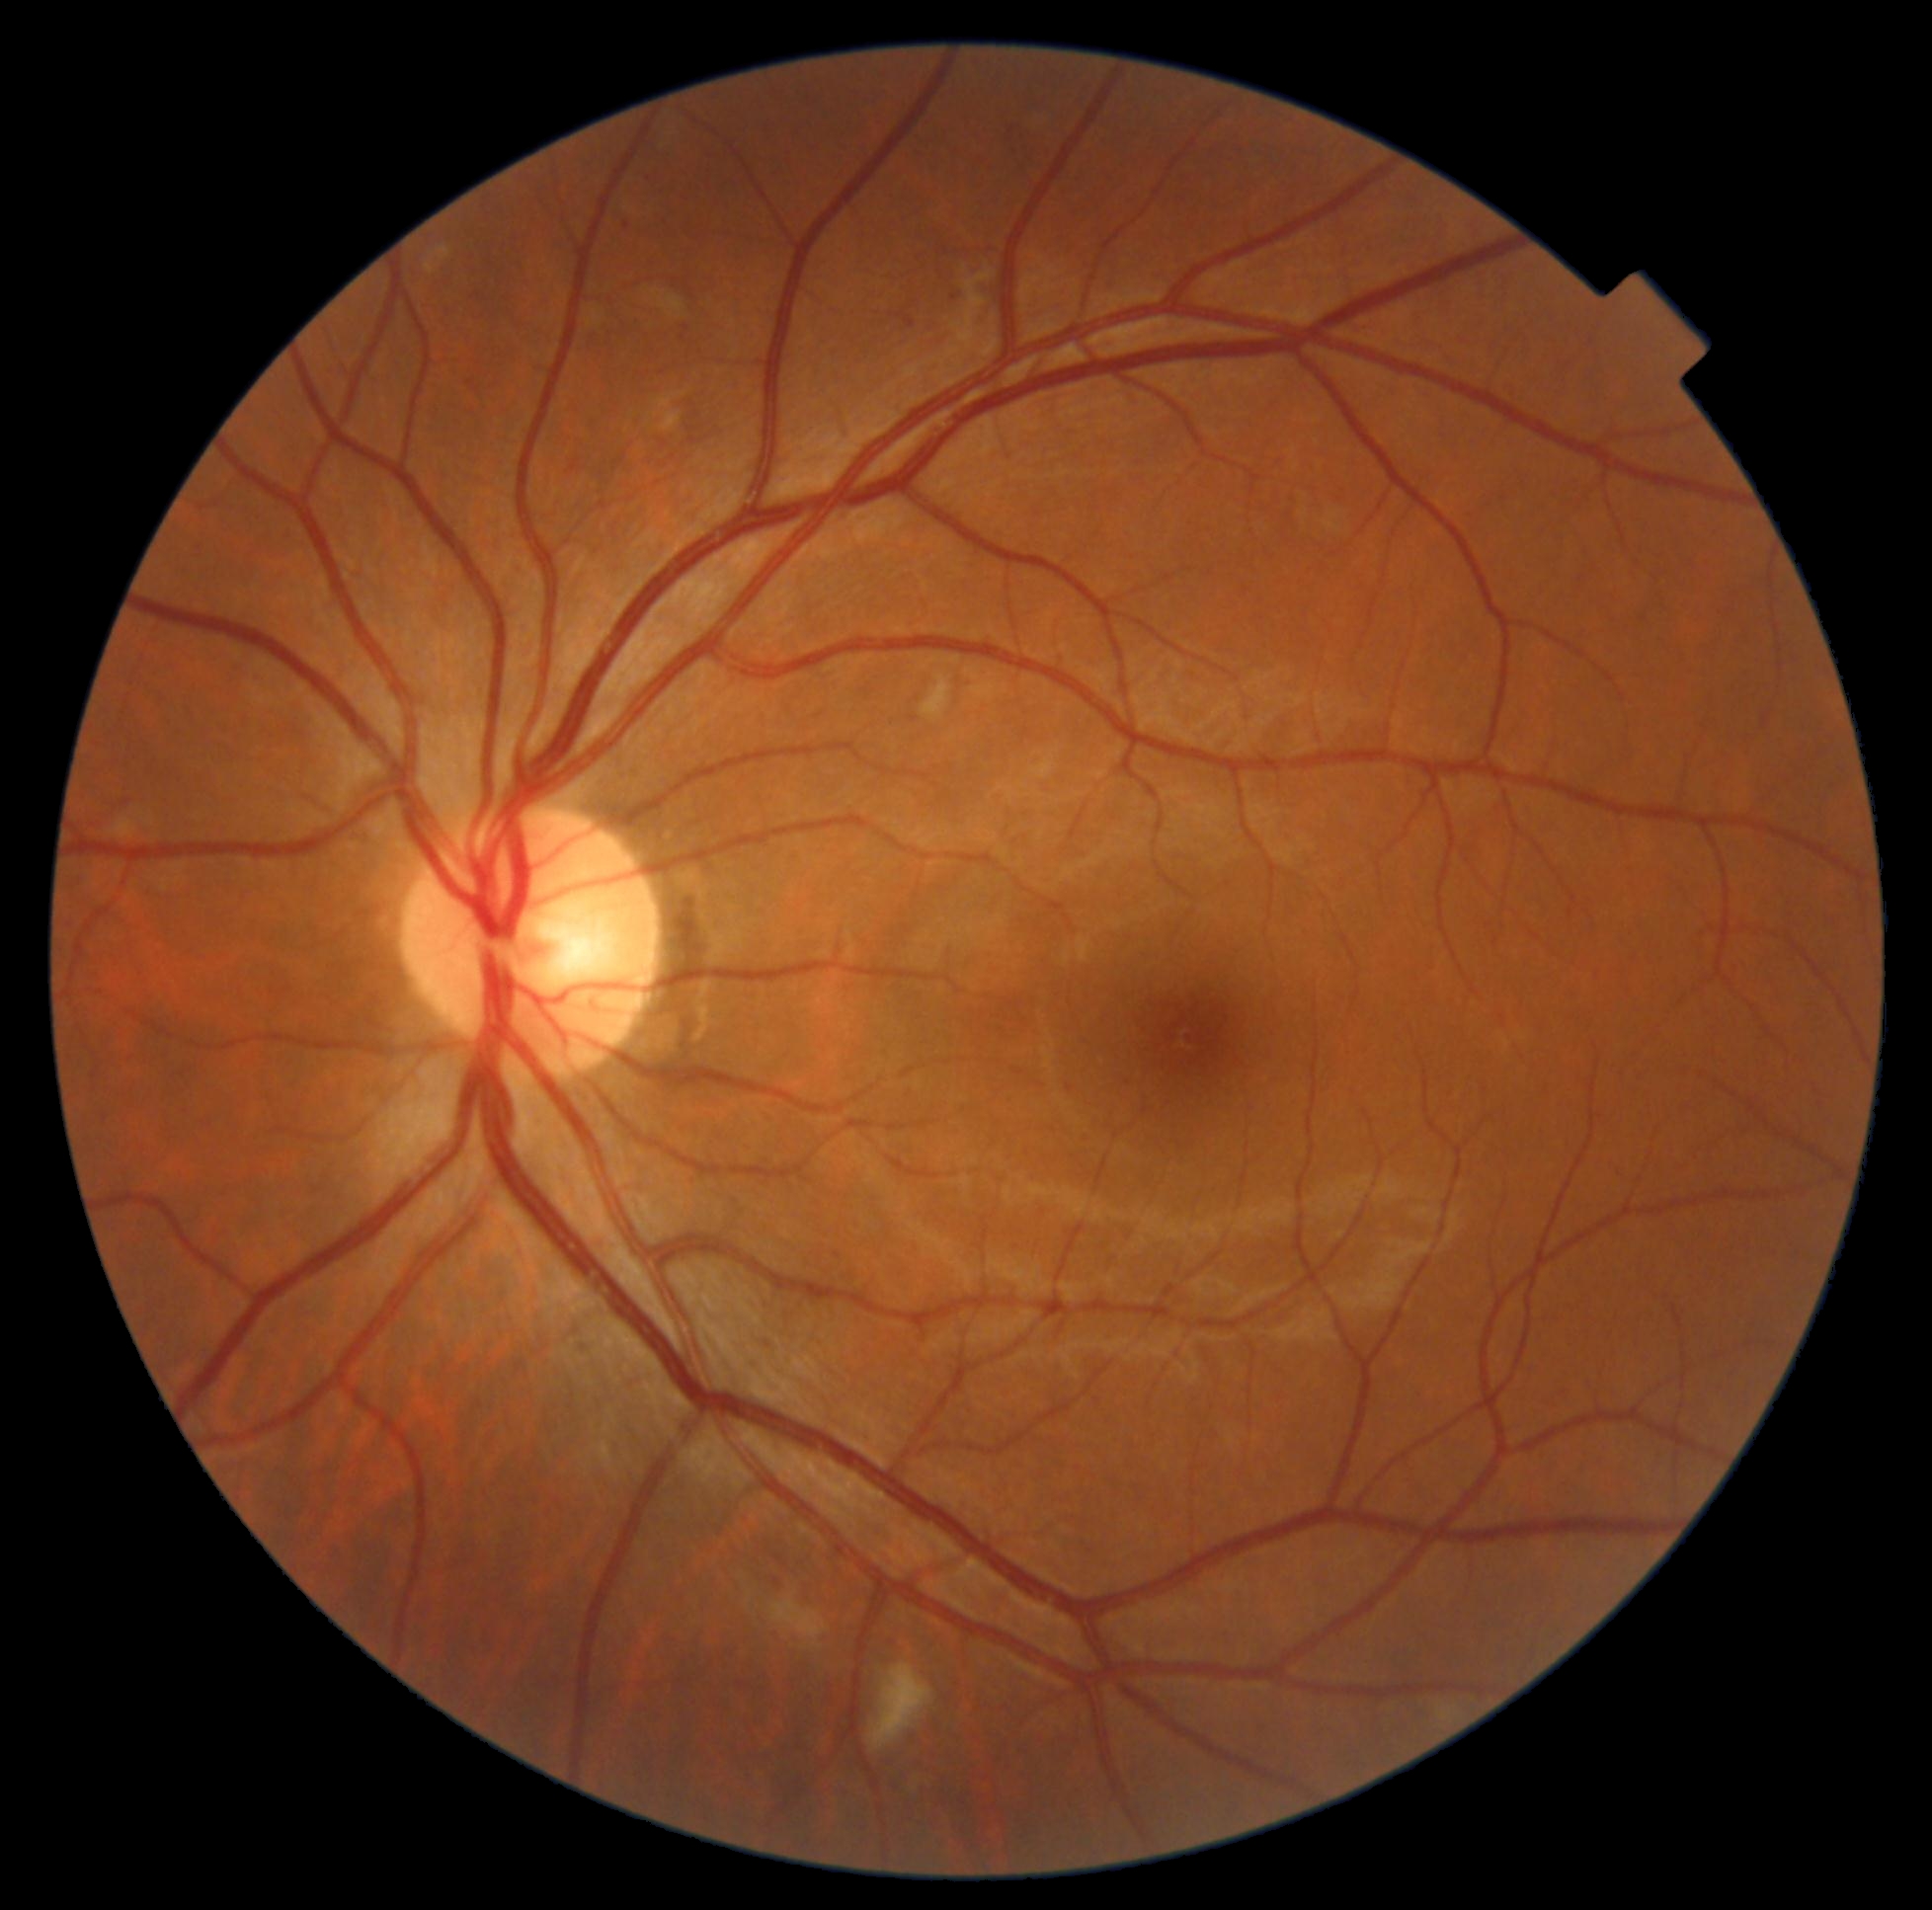

DR severity: 2/4.